Pachymetry: 503 µm · non-mydriatic acquisition · refraction: sphere +0.75 D, cylinder -0.25 D, axis 90° · age 55 · captured on a Topcon TRC-NW400 fundus camera · sex: F:
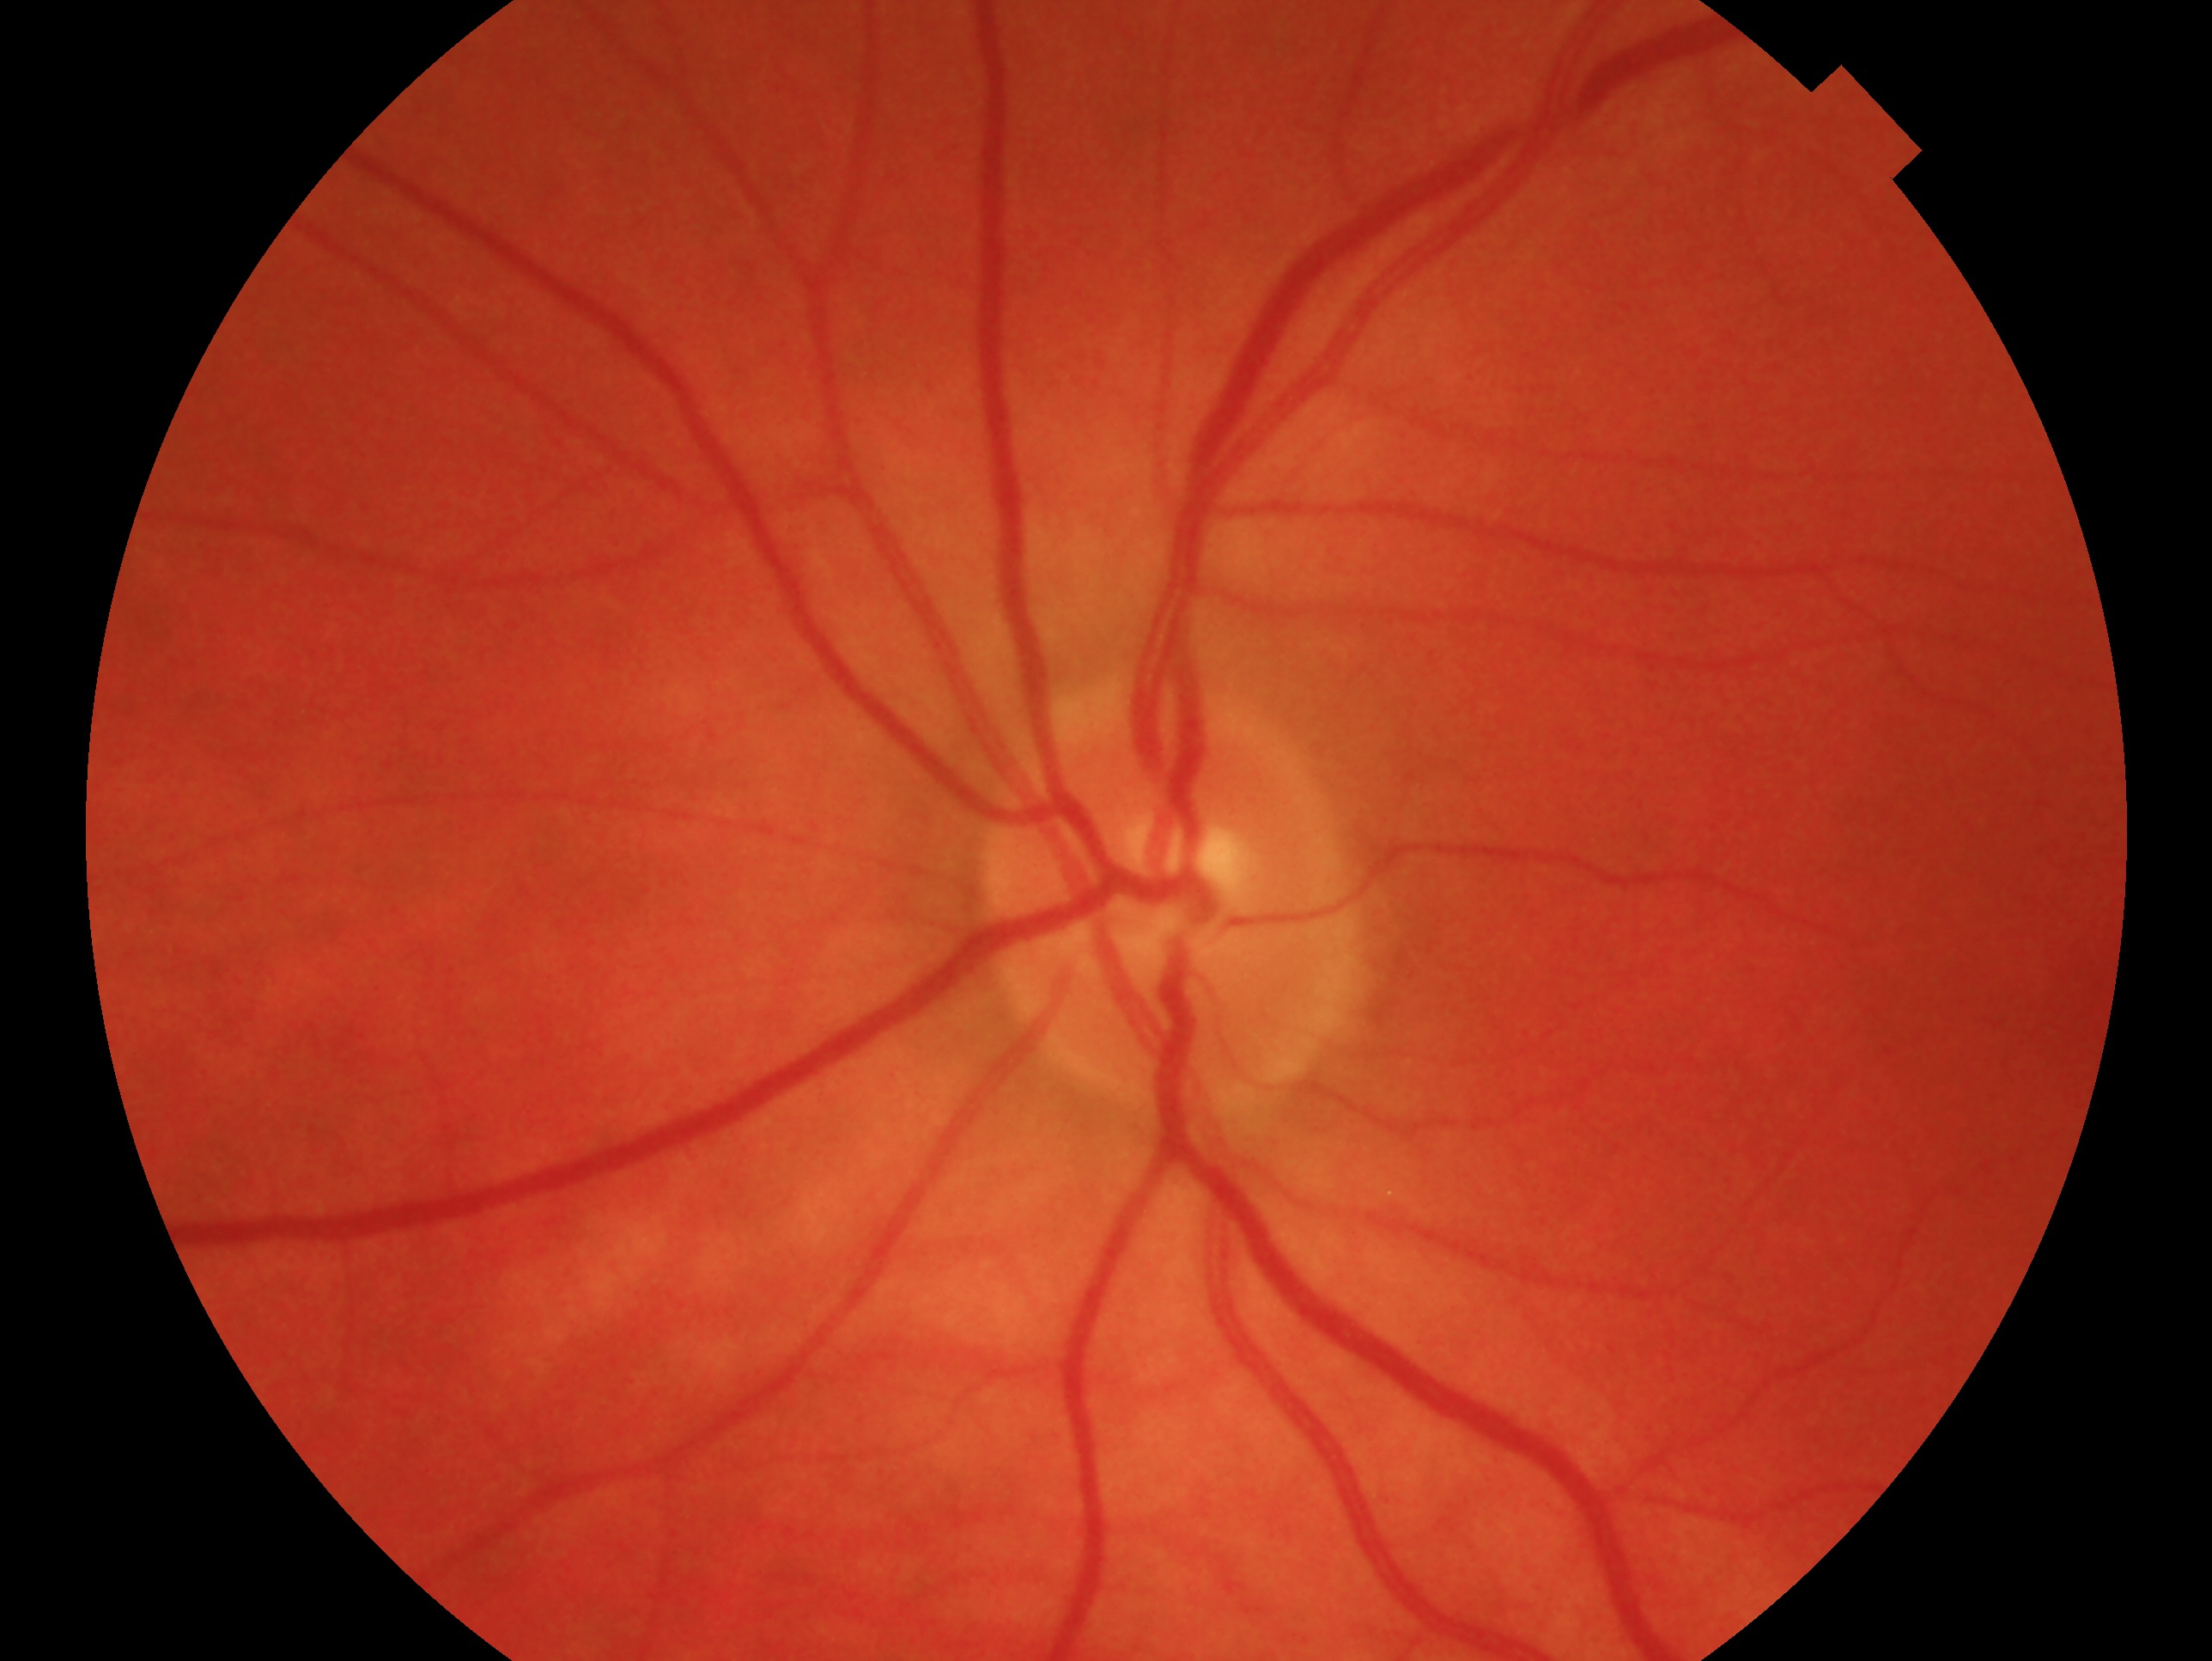

Q: Right or left eye?
A: left eye
Q: Glaucoma classification?
A: no signs of glaucoma